Infant wide-field retinal image. Image size 1240x1240: 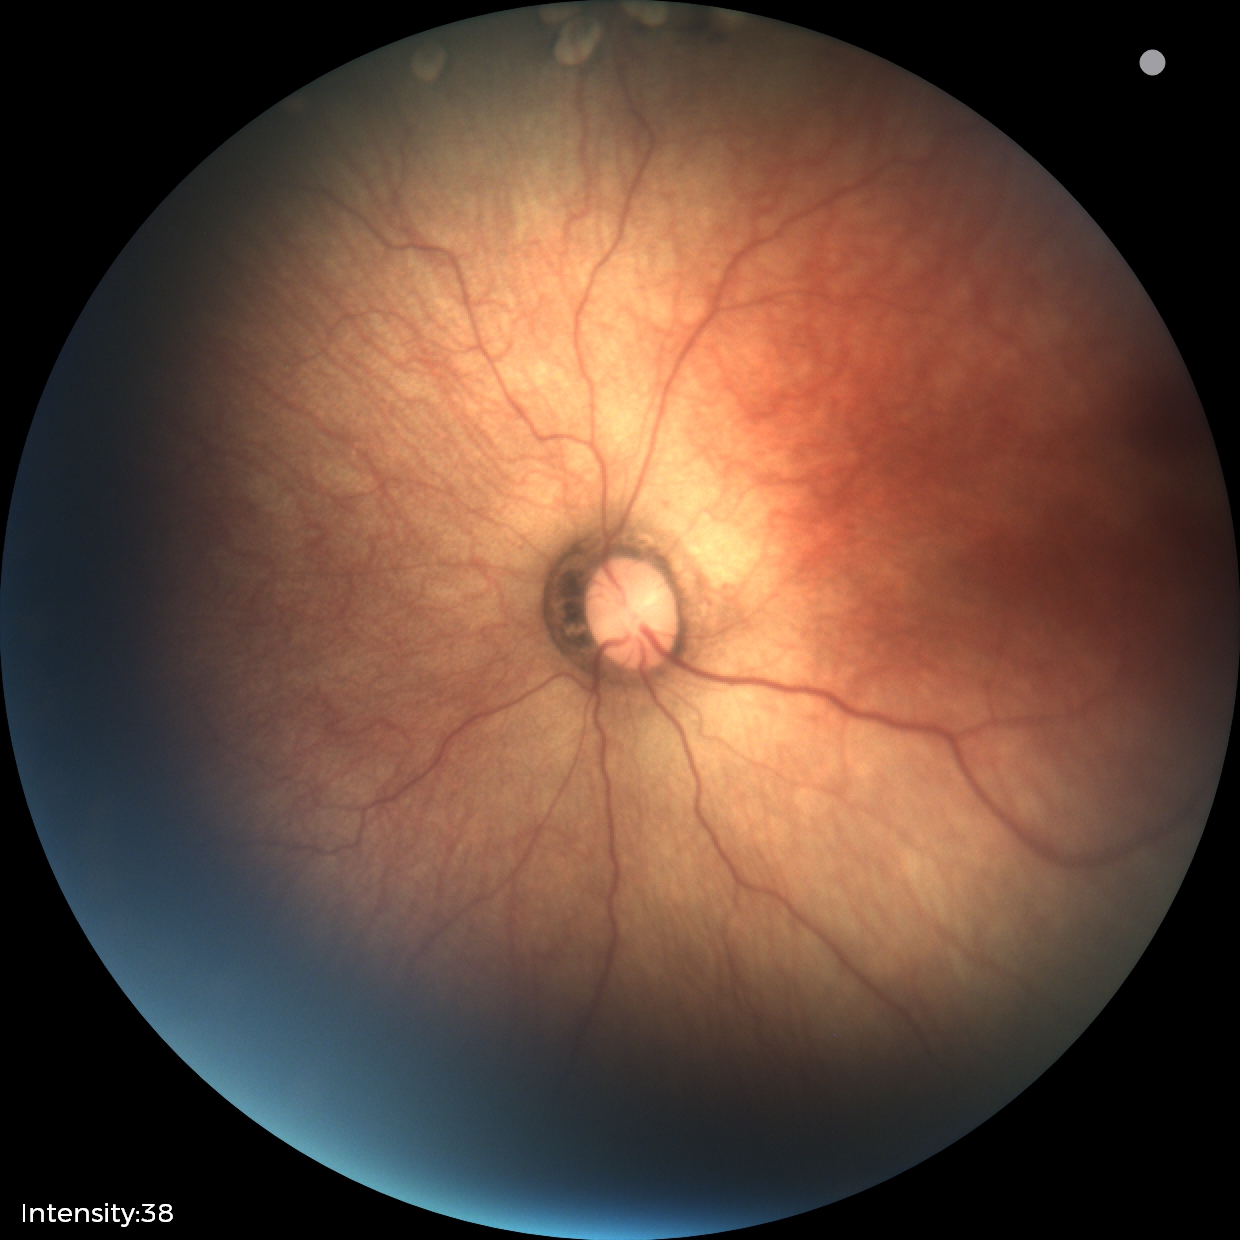 Examination diagnosed as status post retinopathy of prematurity. Without plus disease.